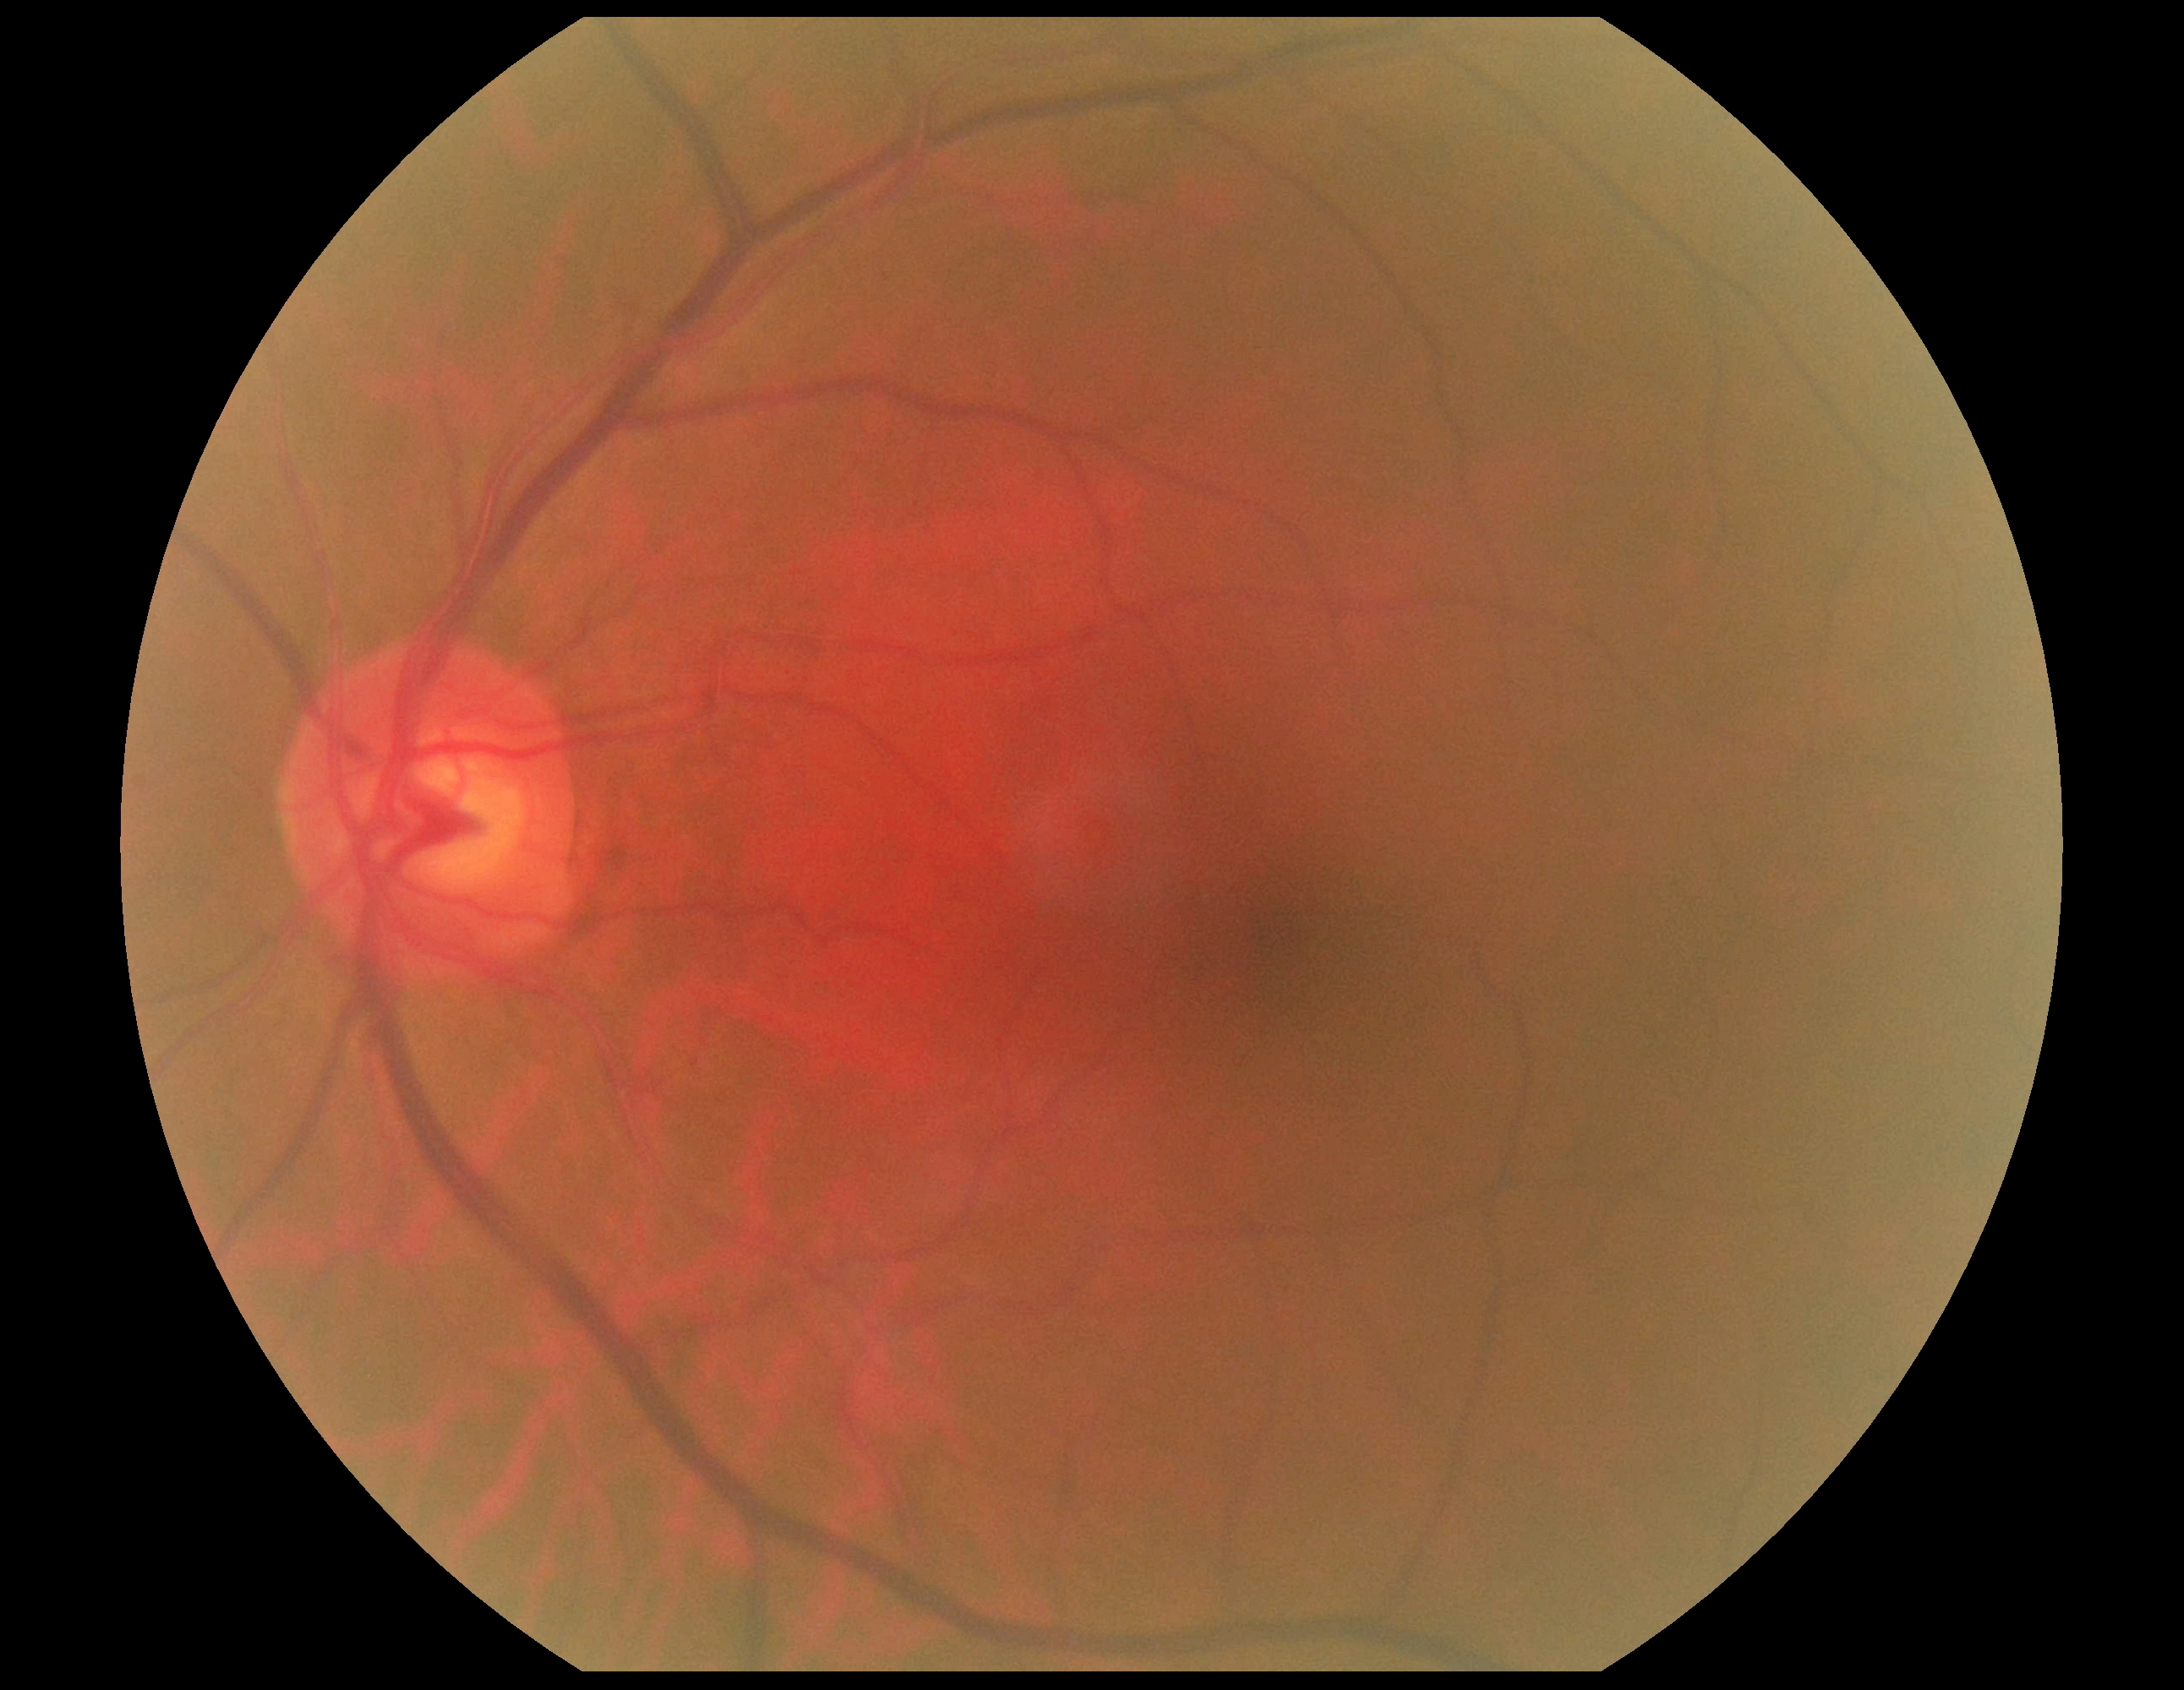

Diabetic retinopathy: grade 0 — no visible signs of diabetic retinopathy.